Infant wide-field fundus photograph. Image size 640x480:
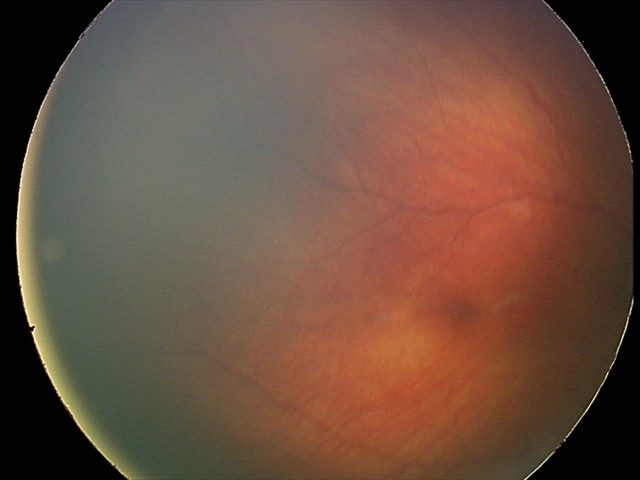
Diagnosis from this screening exam: retinal hemorrhages.